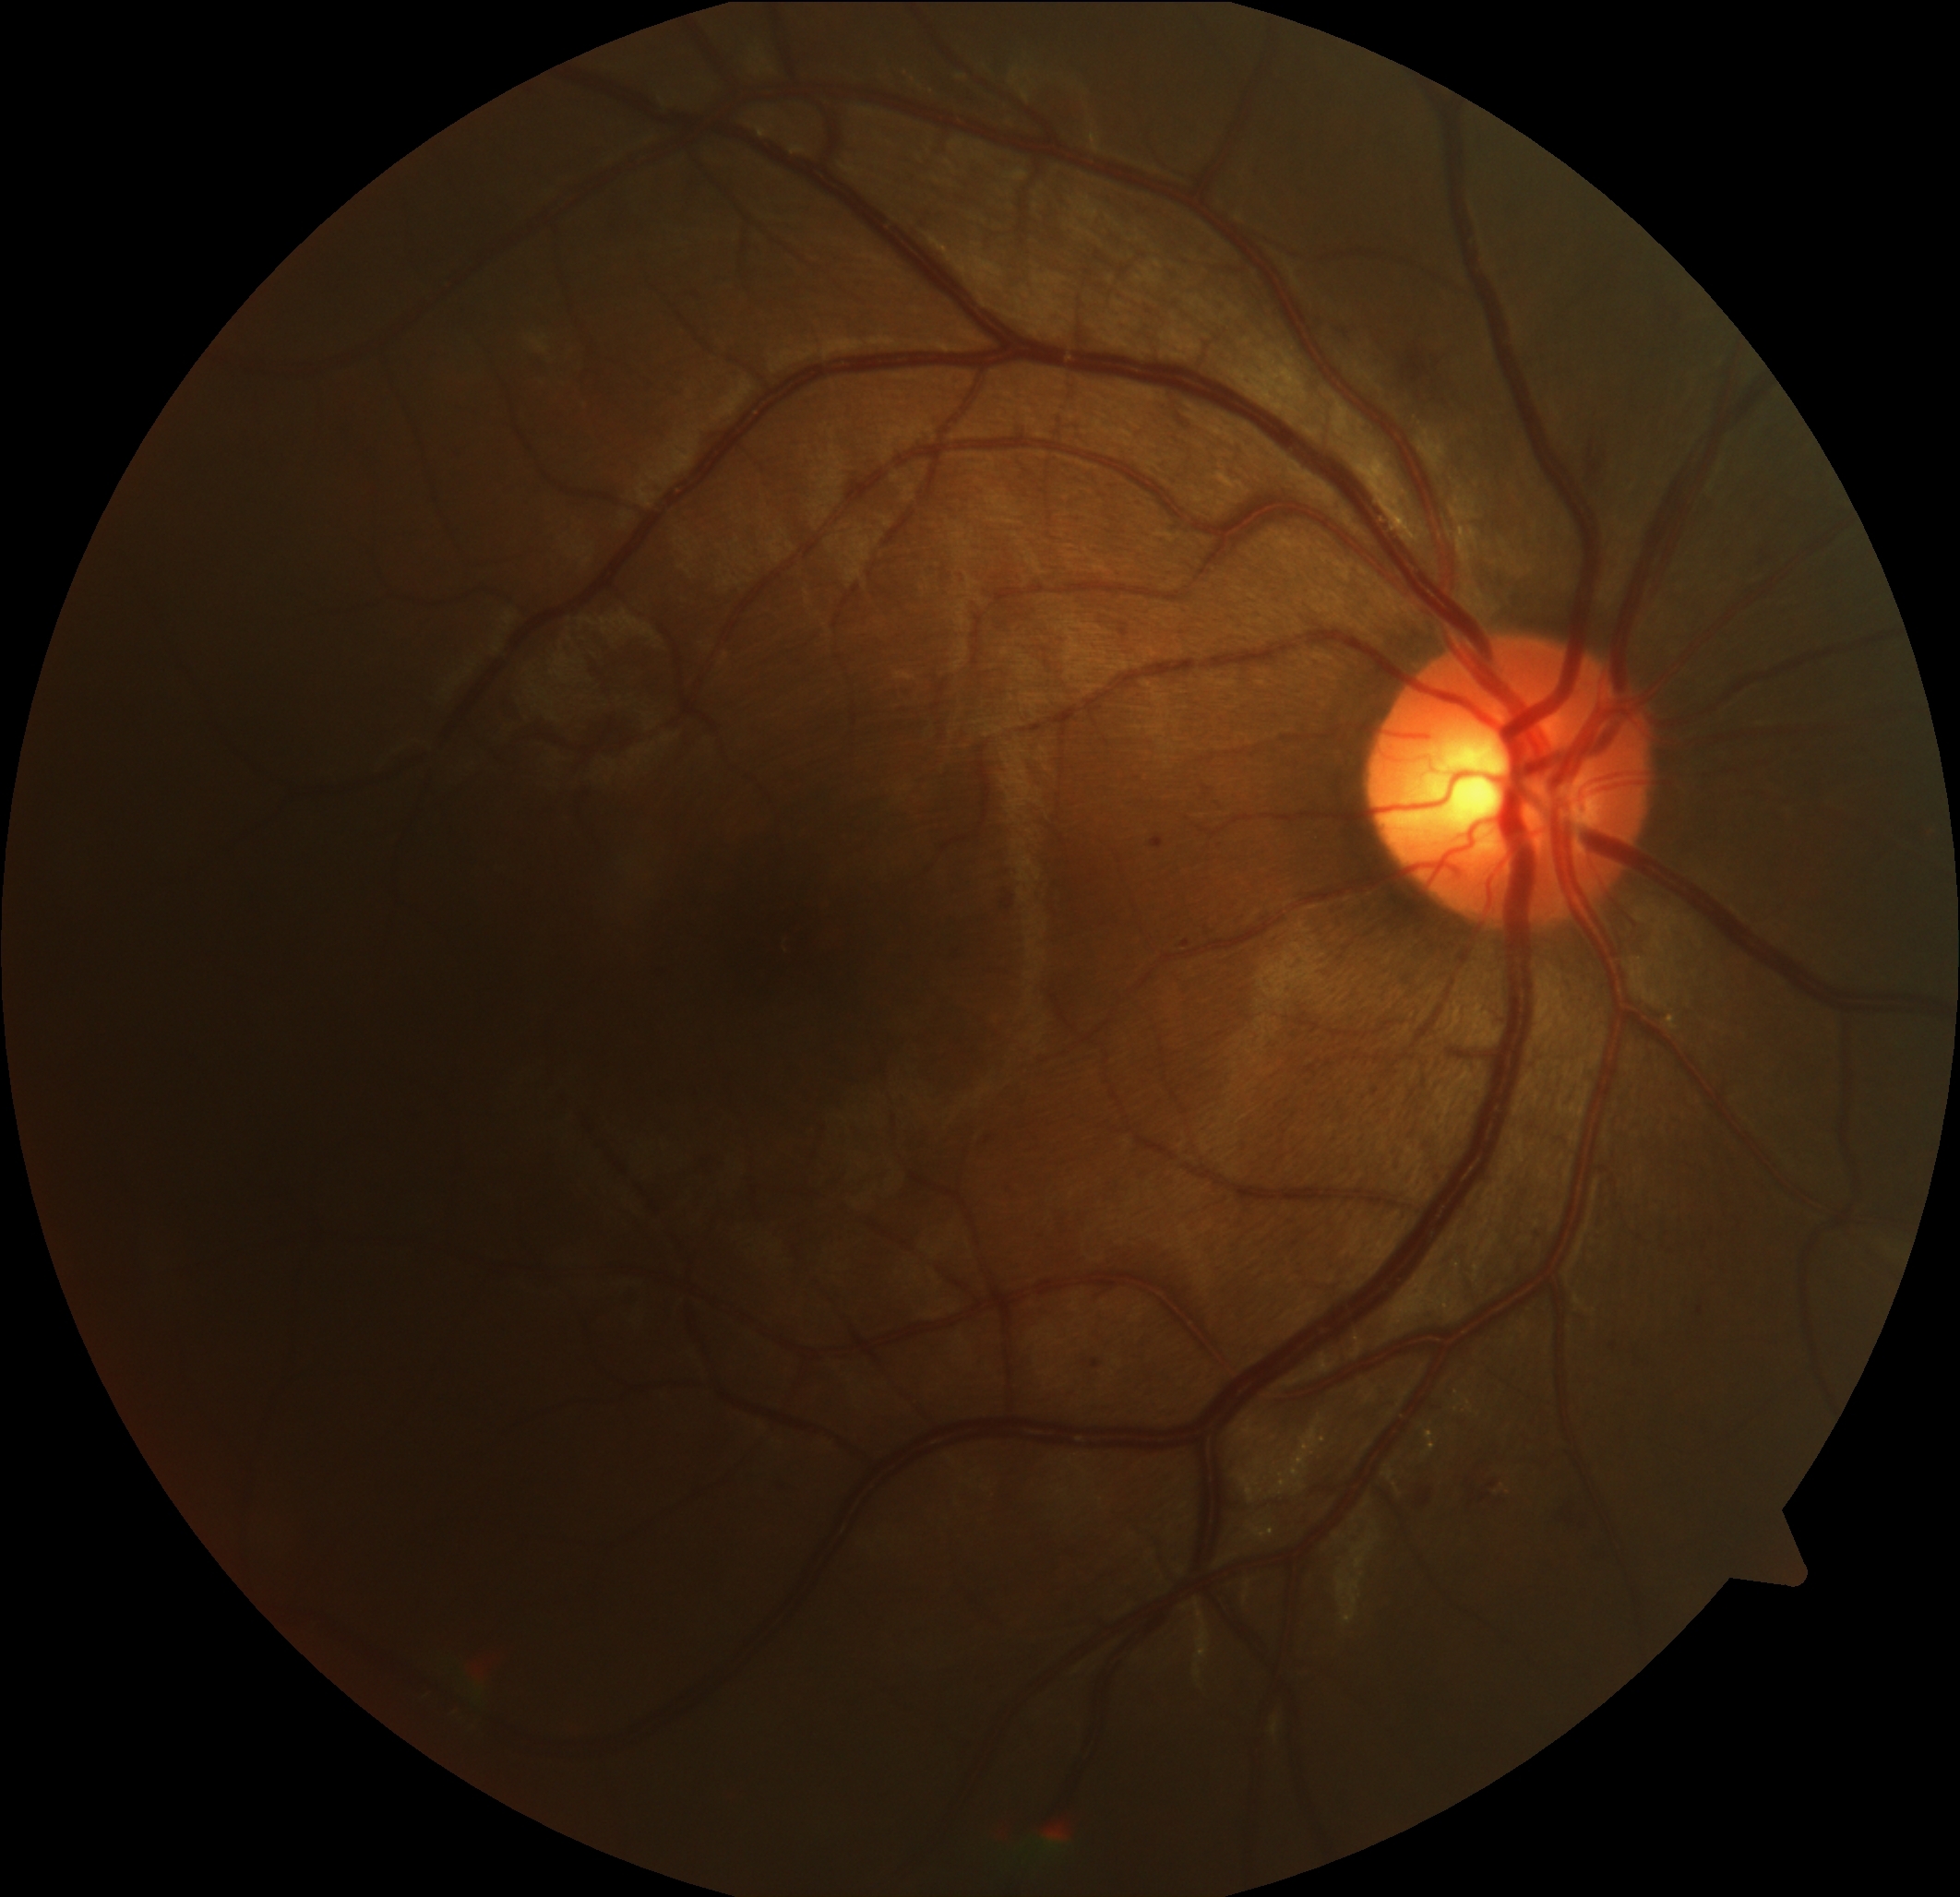 • DR severity — 2